1932 by 1932 pixels · 45-degree field of view · retinal fundus photograph:
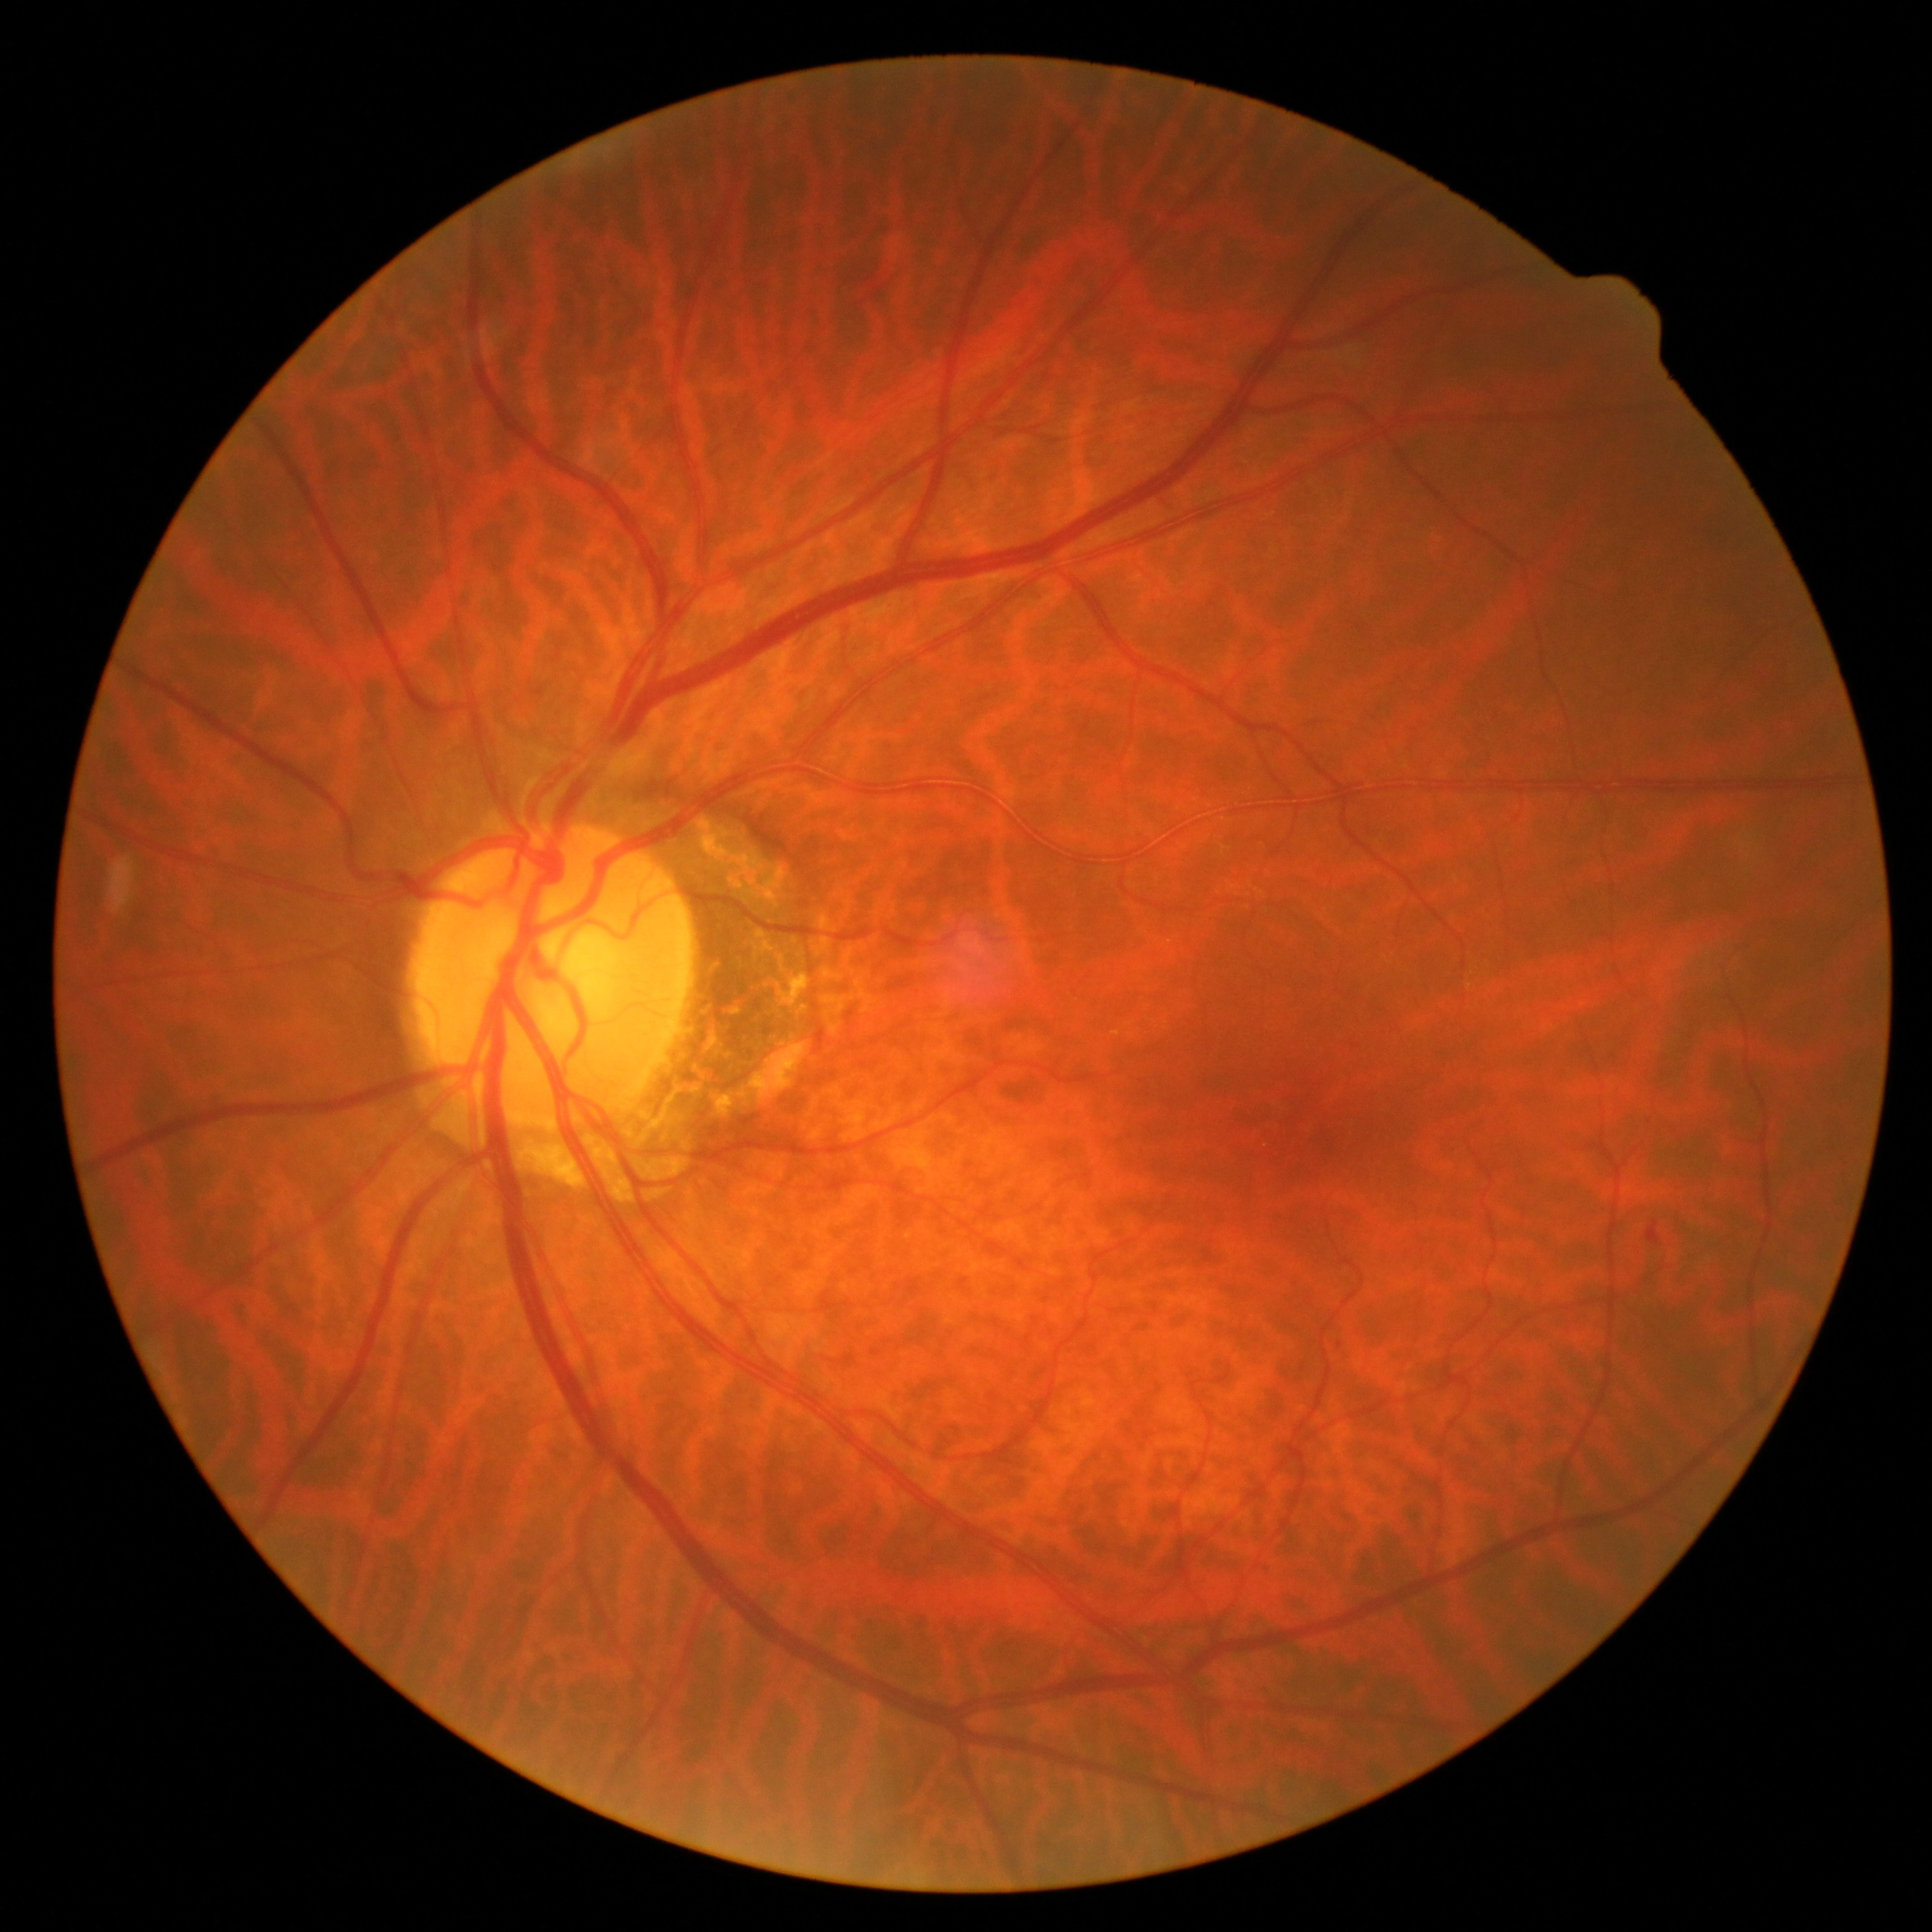
Findings:
* DR class — non-proliferative diabetic retinopathy
* DR grade — moderate NPDR (2)